FOV: 45 degrees. 2352x1568px. Color fundus image — 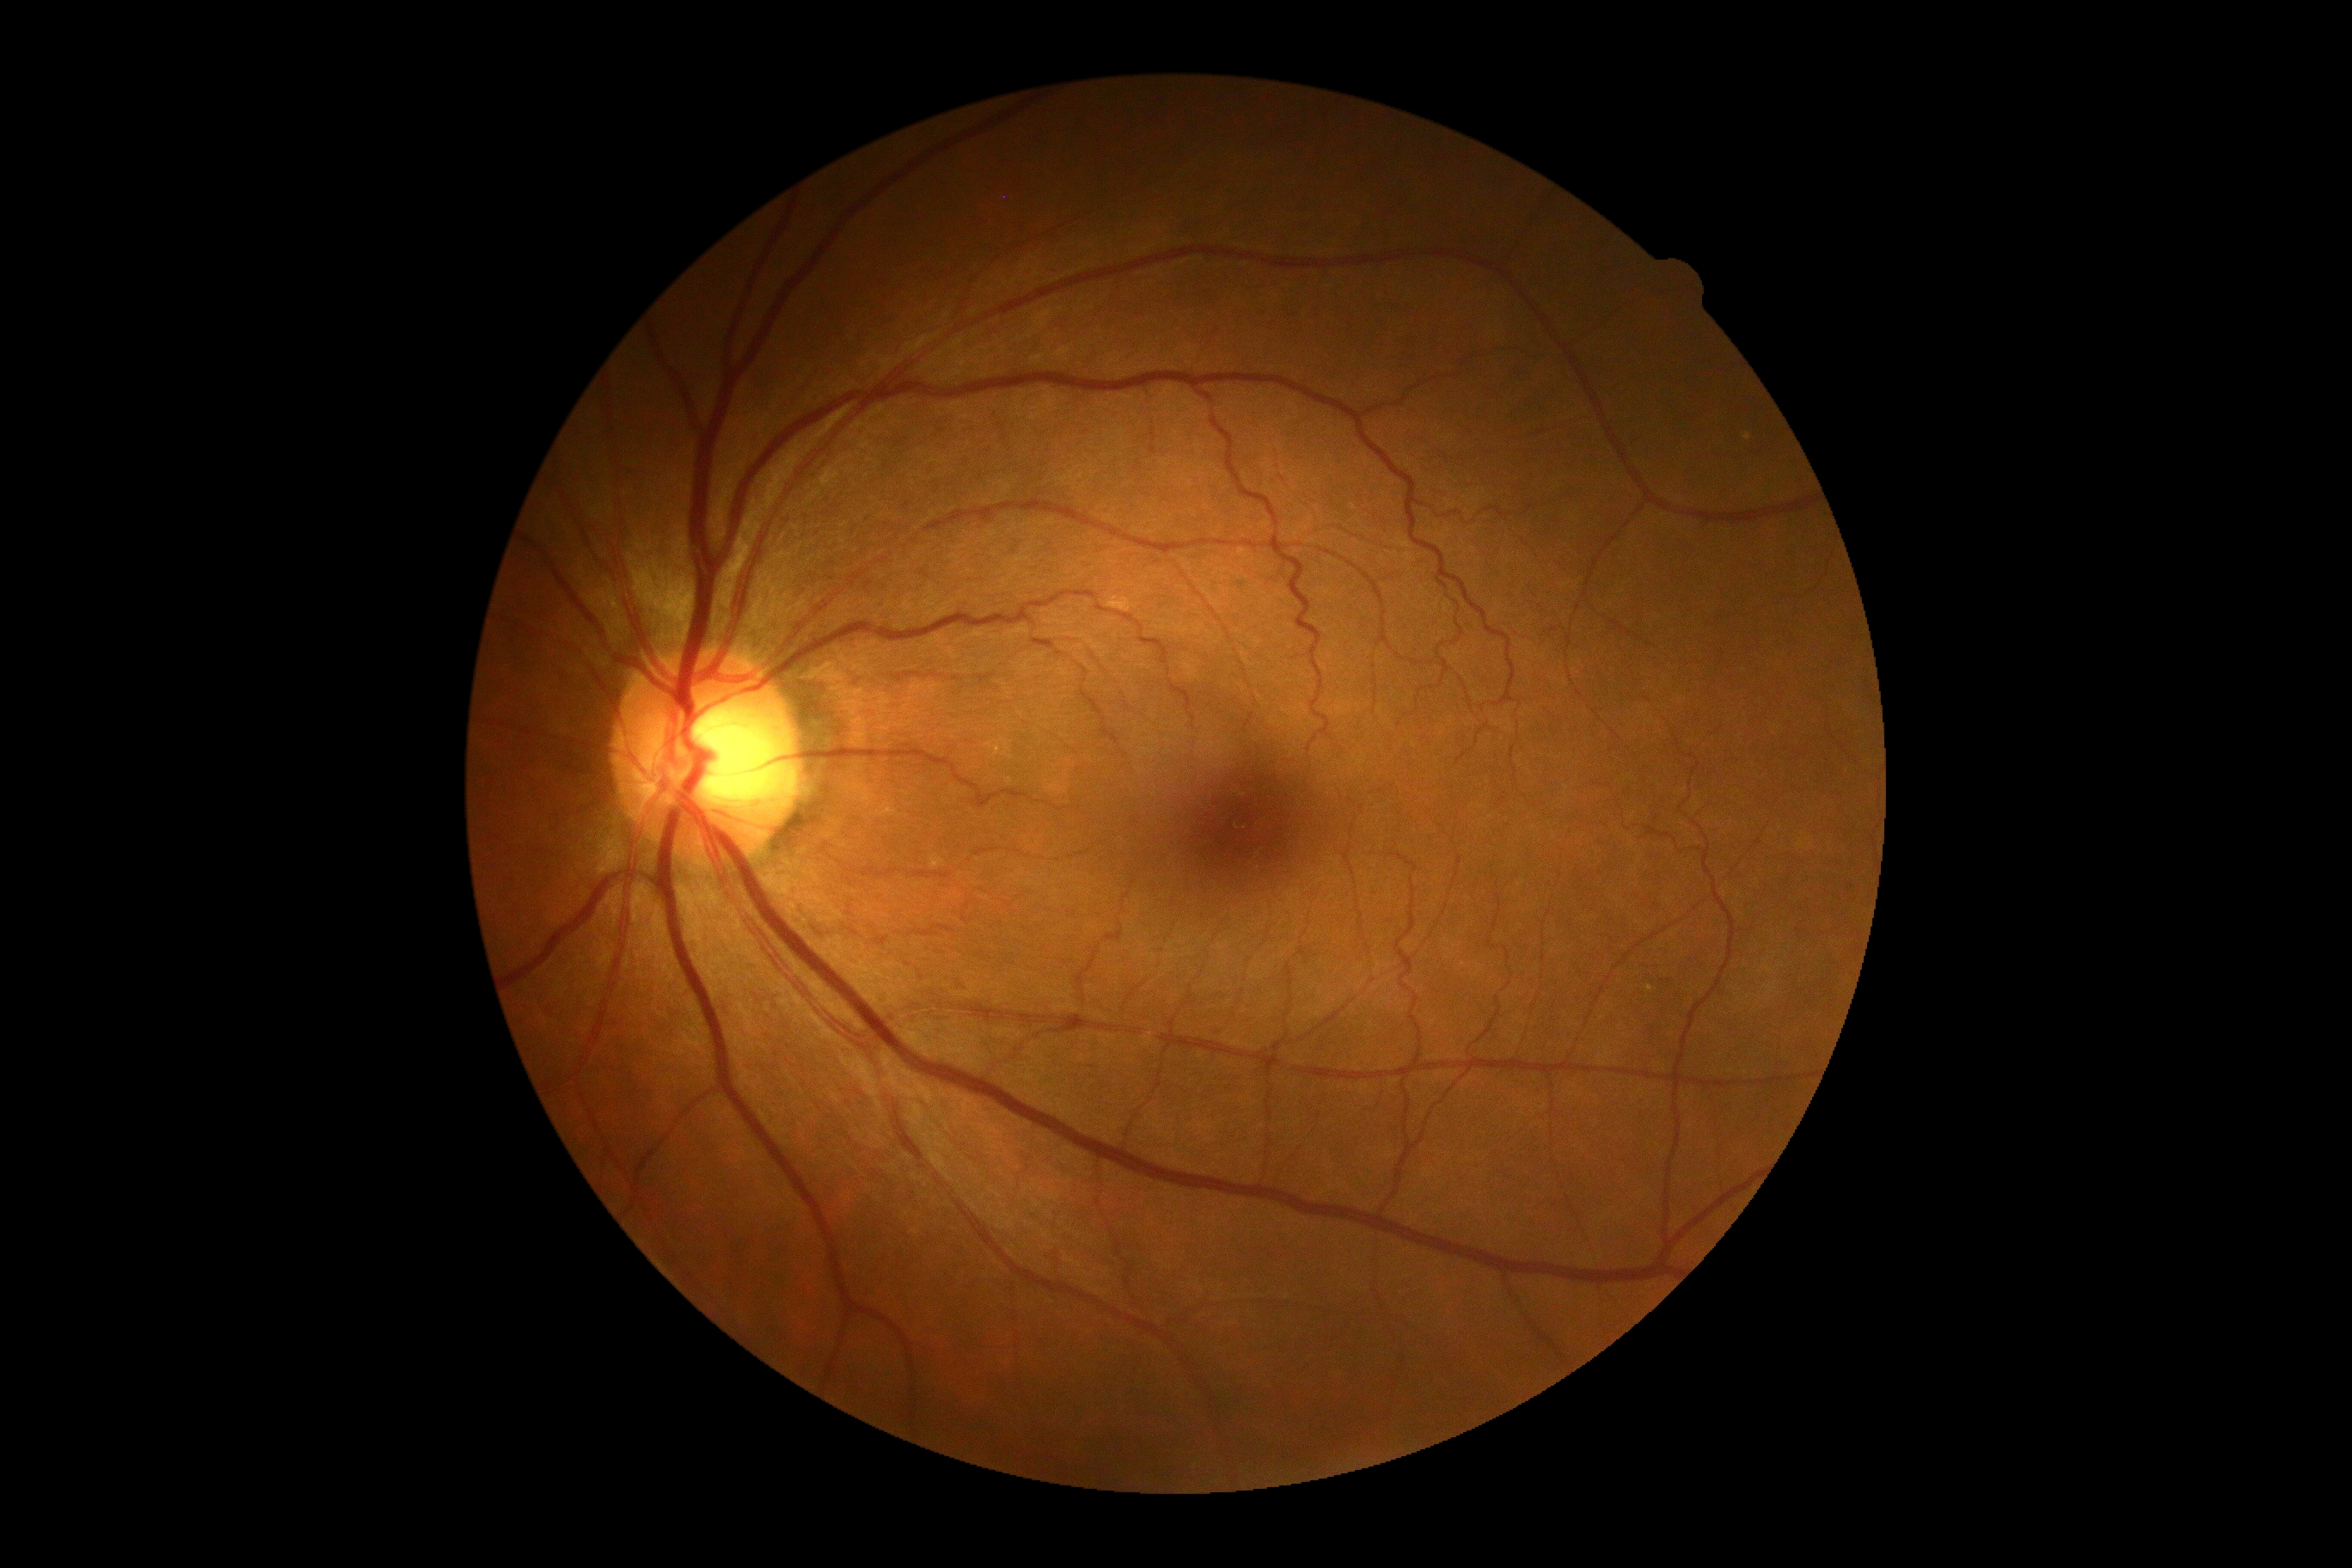 No apparent diabetic retinopathy.
DR grade: 0/4.